Color fundus photograph, 50° field of view:
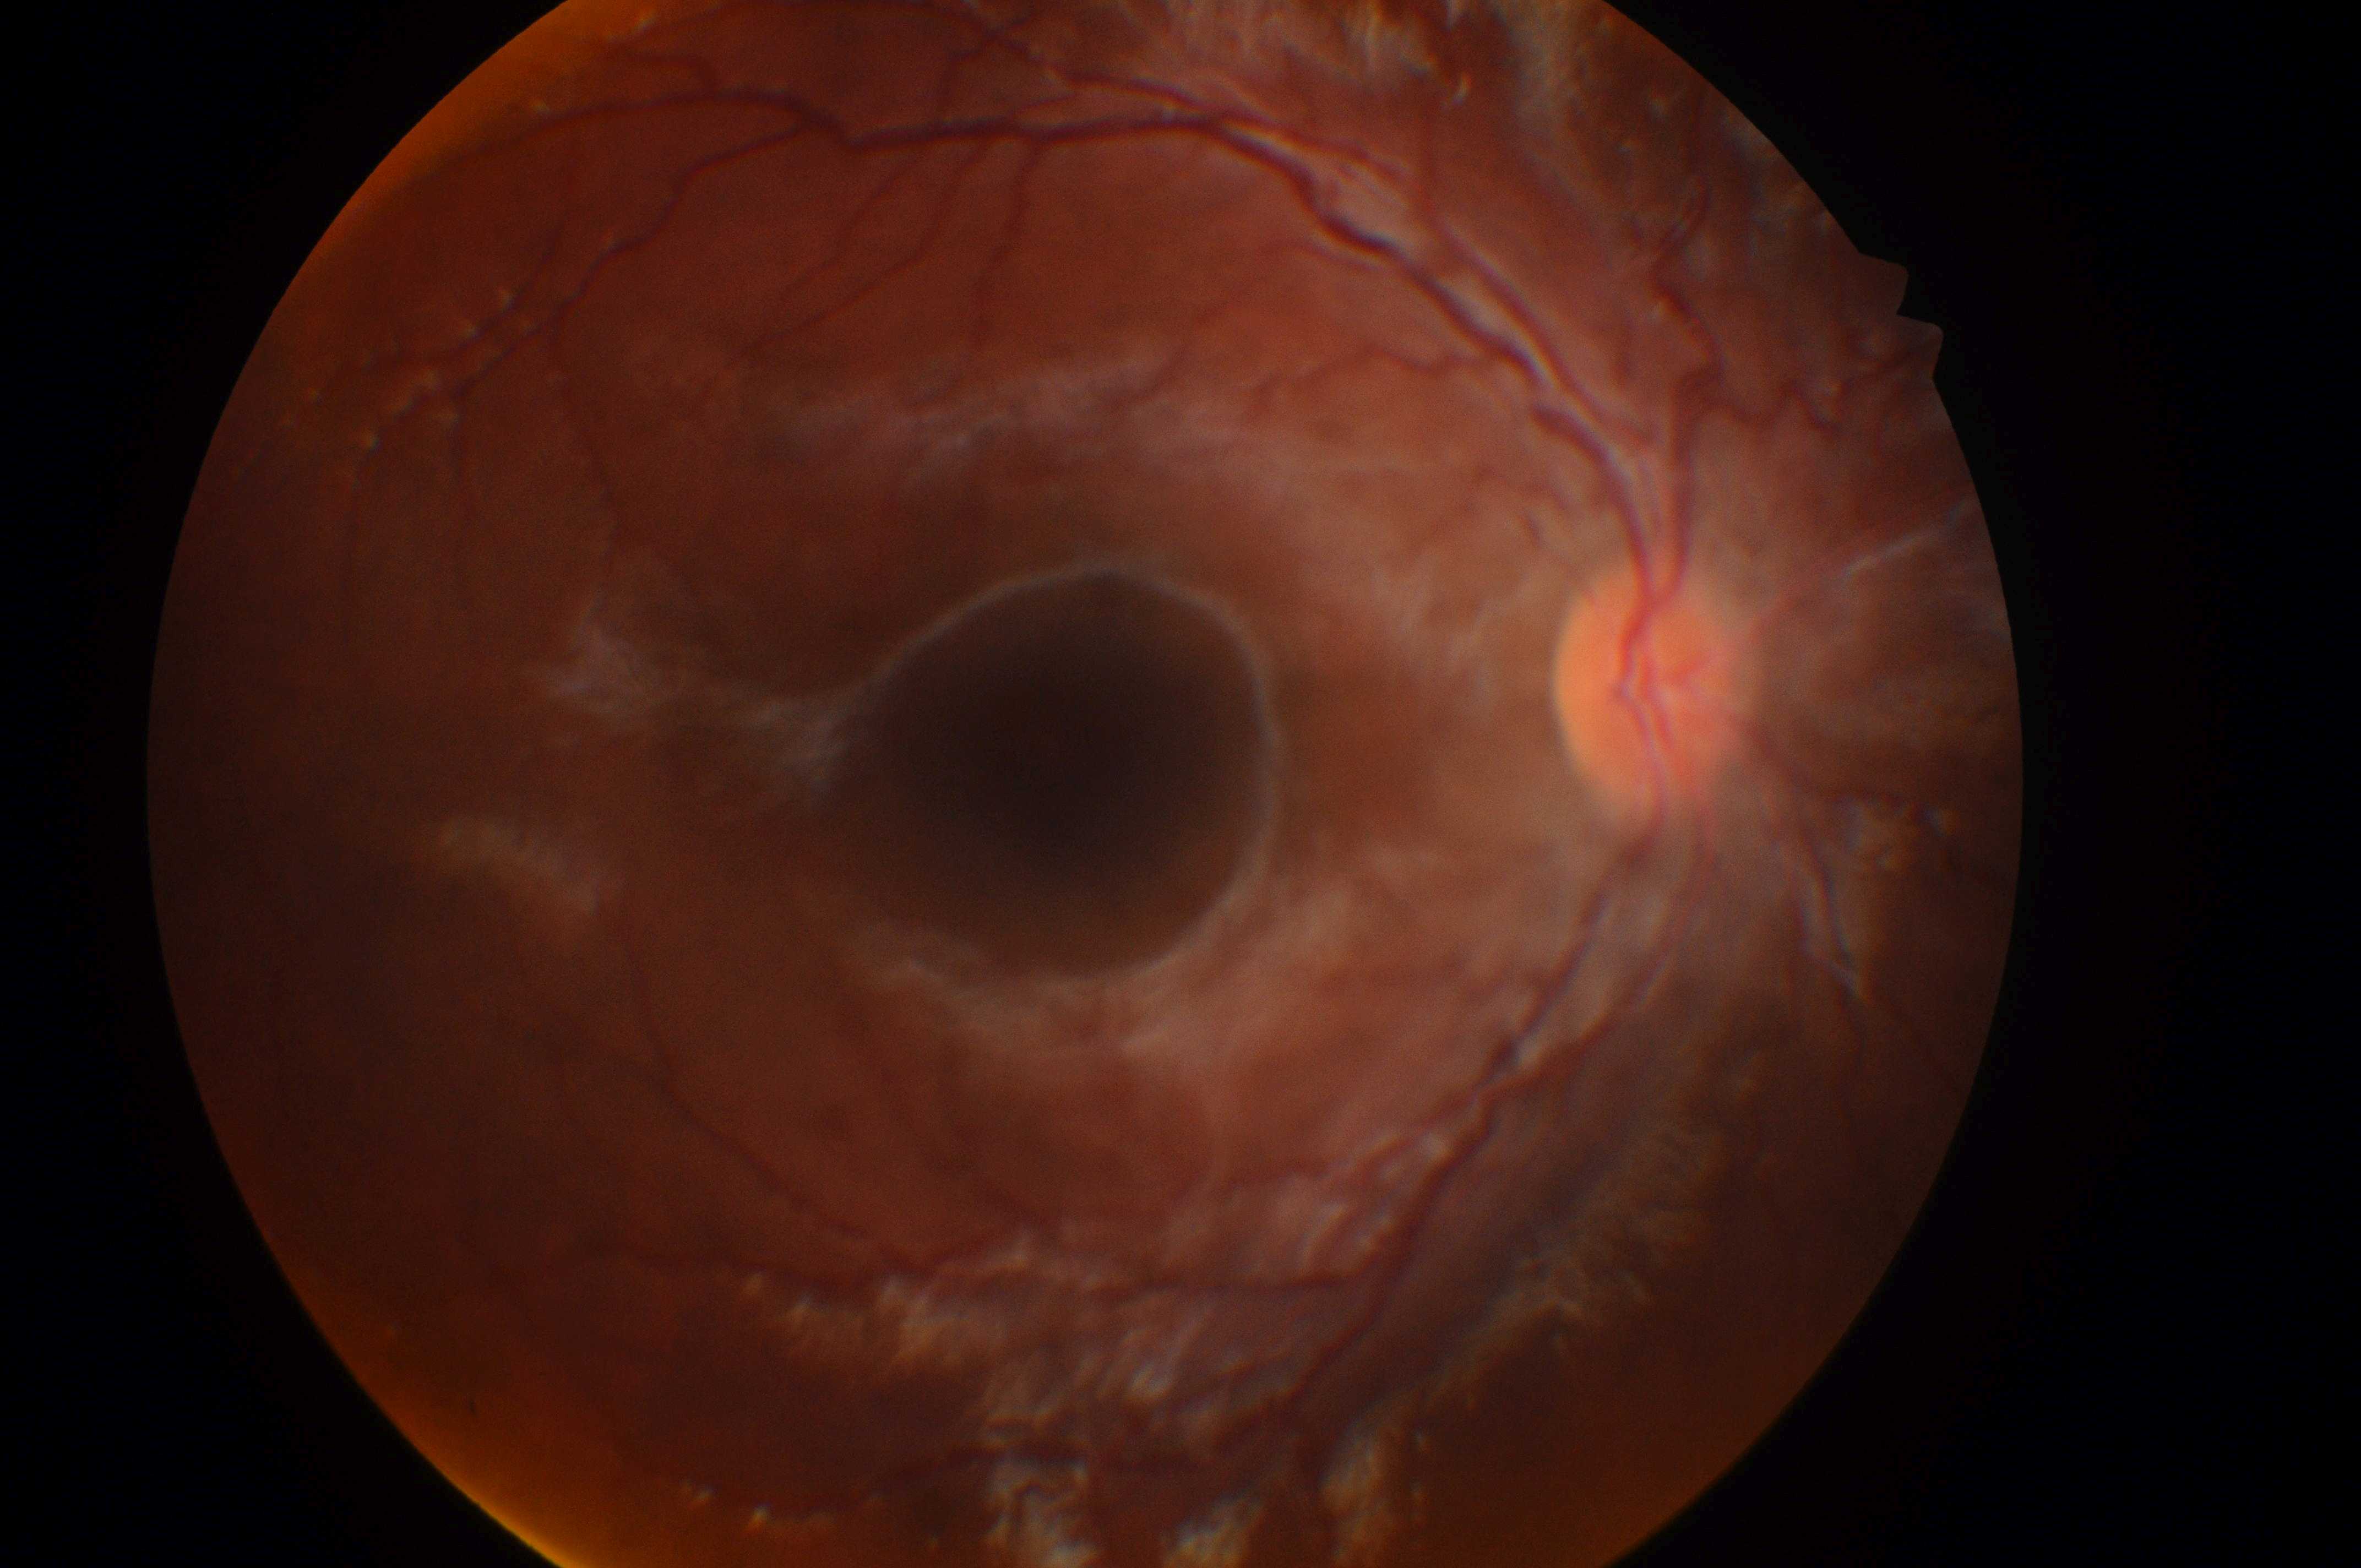

DME is 0.
Eye: oculus dexter.
The optic disc is at x=1646, y=693.
DR is grade 0.
Macular center: x=1054, y=754.